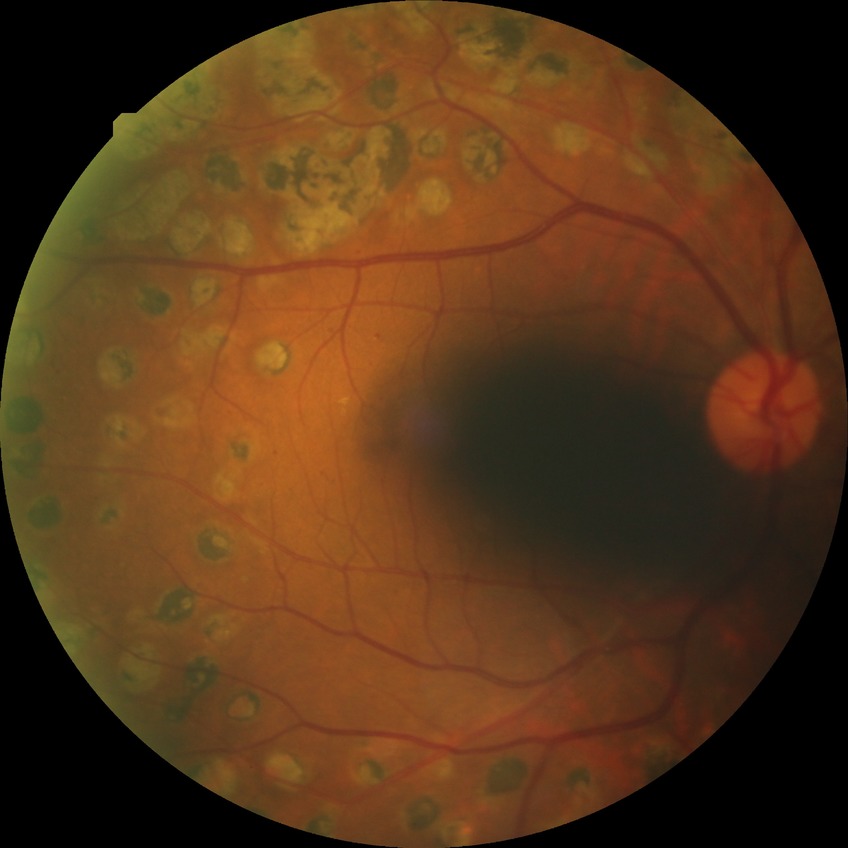

diabetic retinopathy (DR): PDR (proliferative diabetic retinopathy).